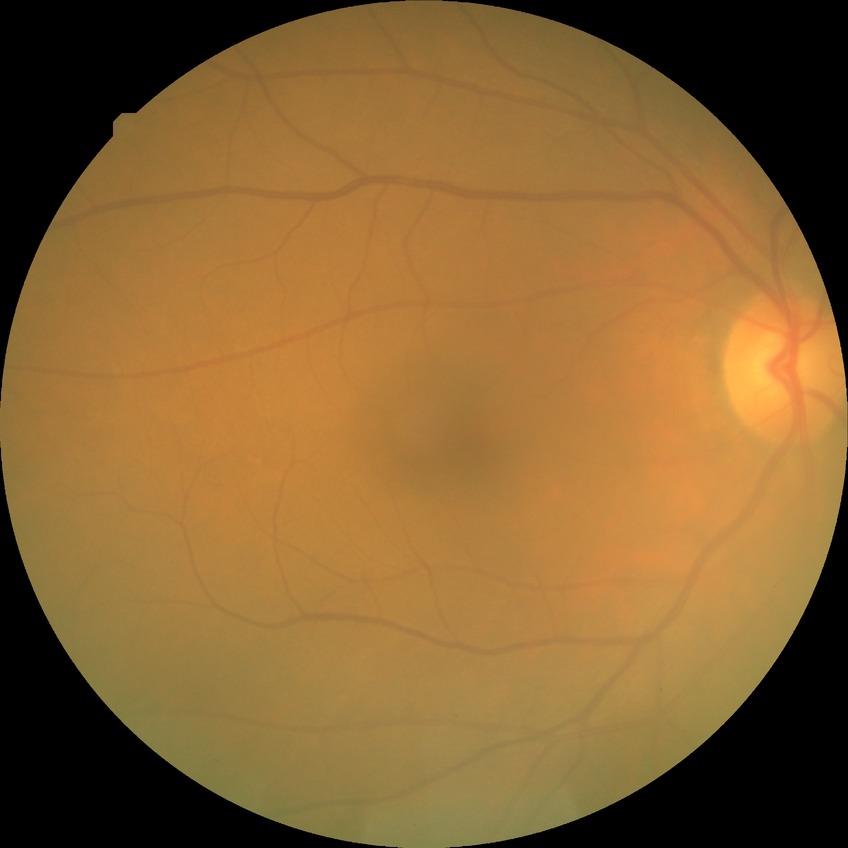

Diabetic retinopathy grade: no diabetic retinopathy.